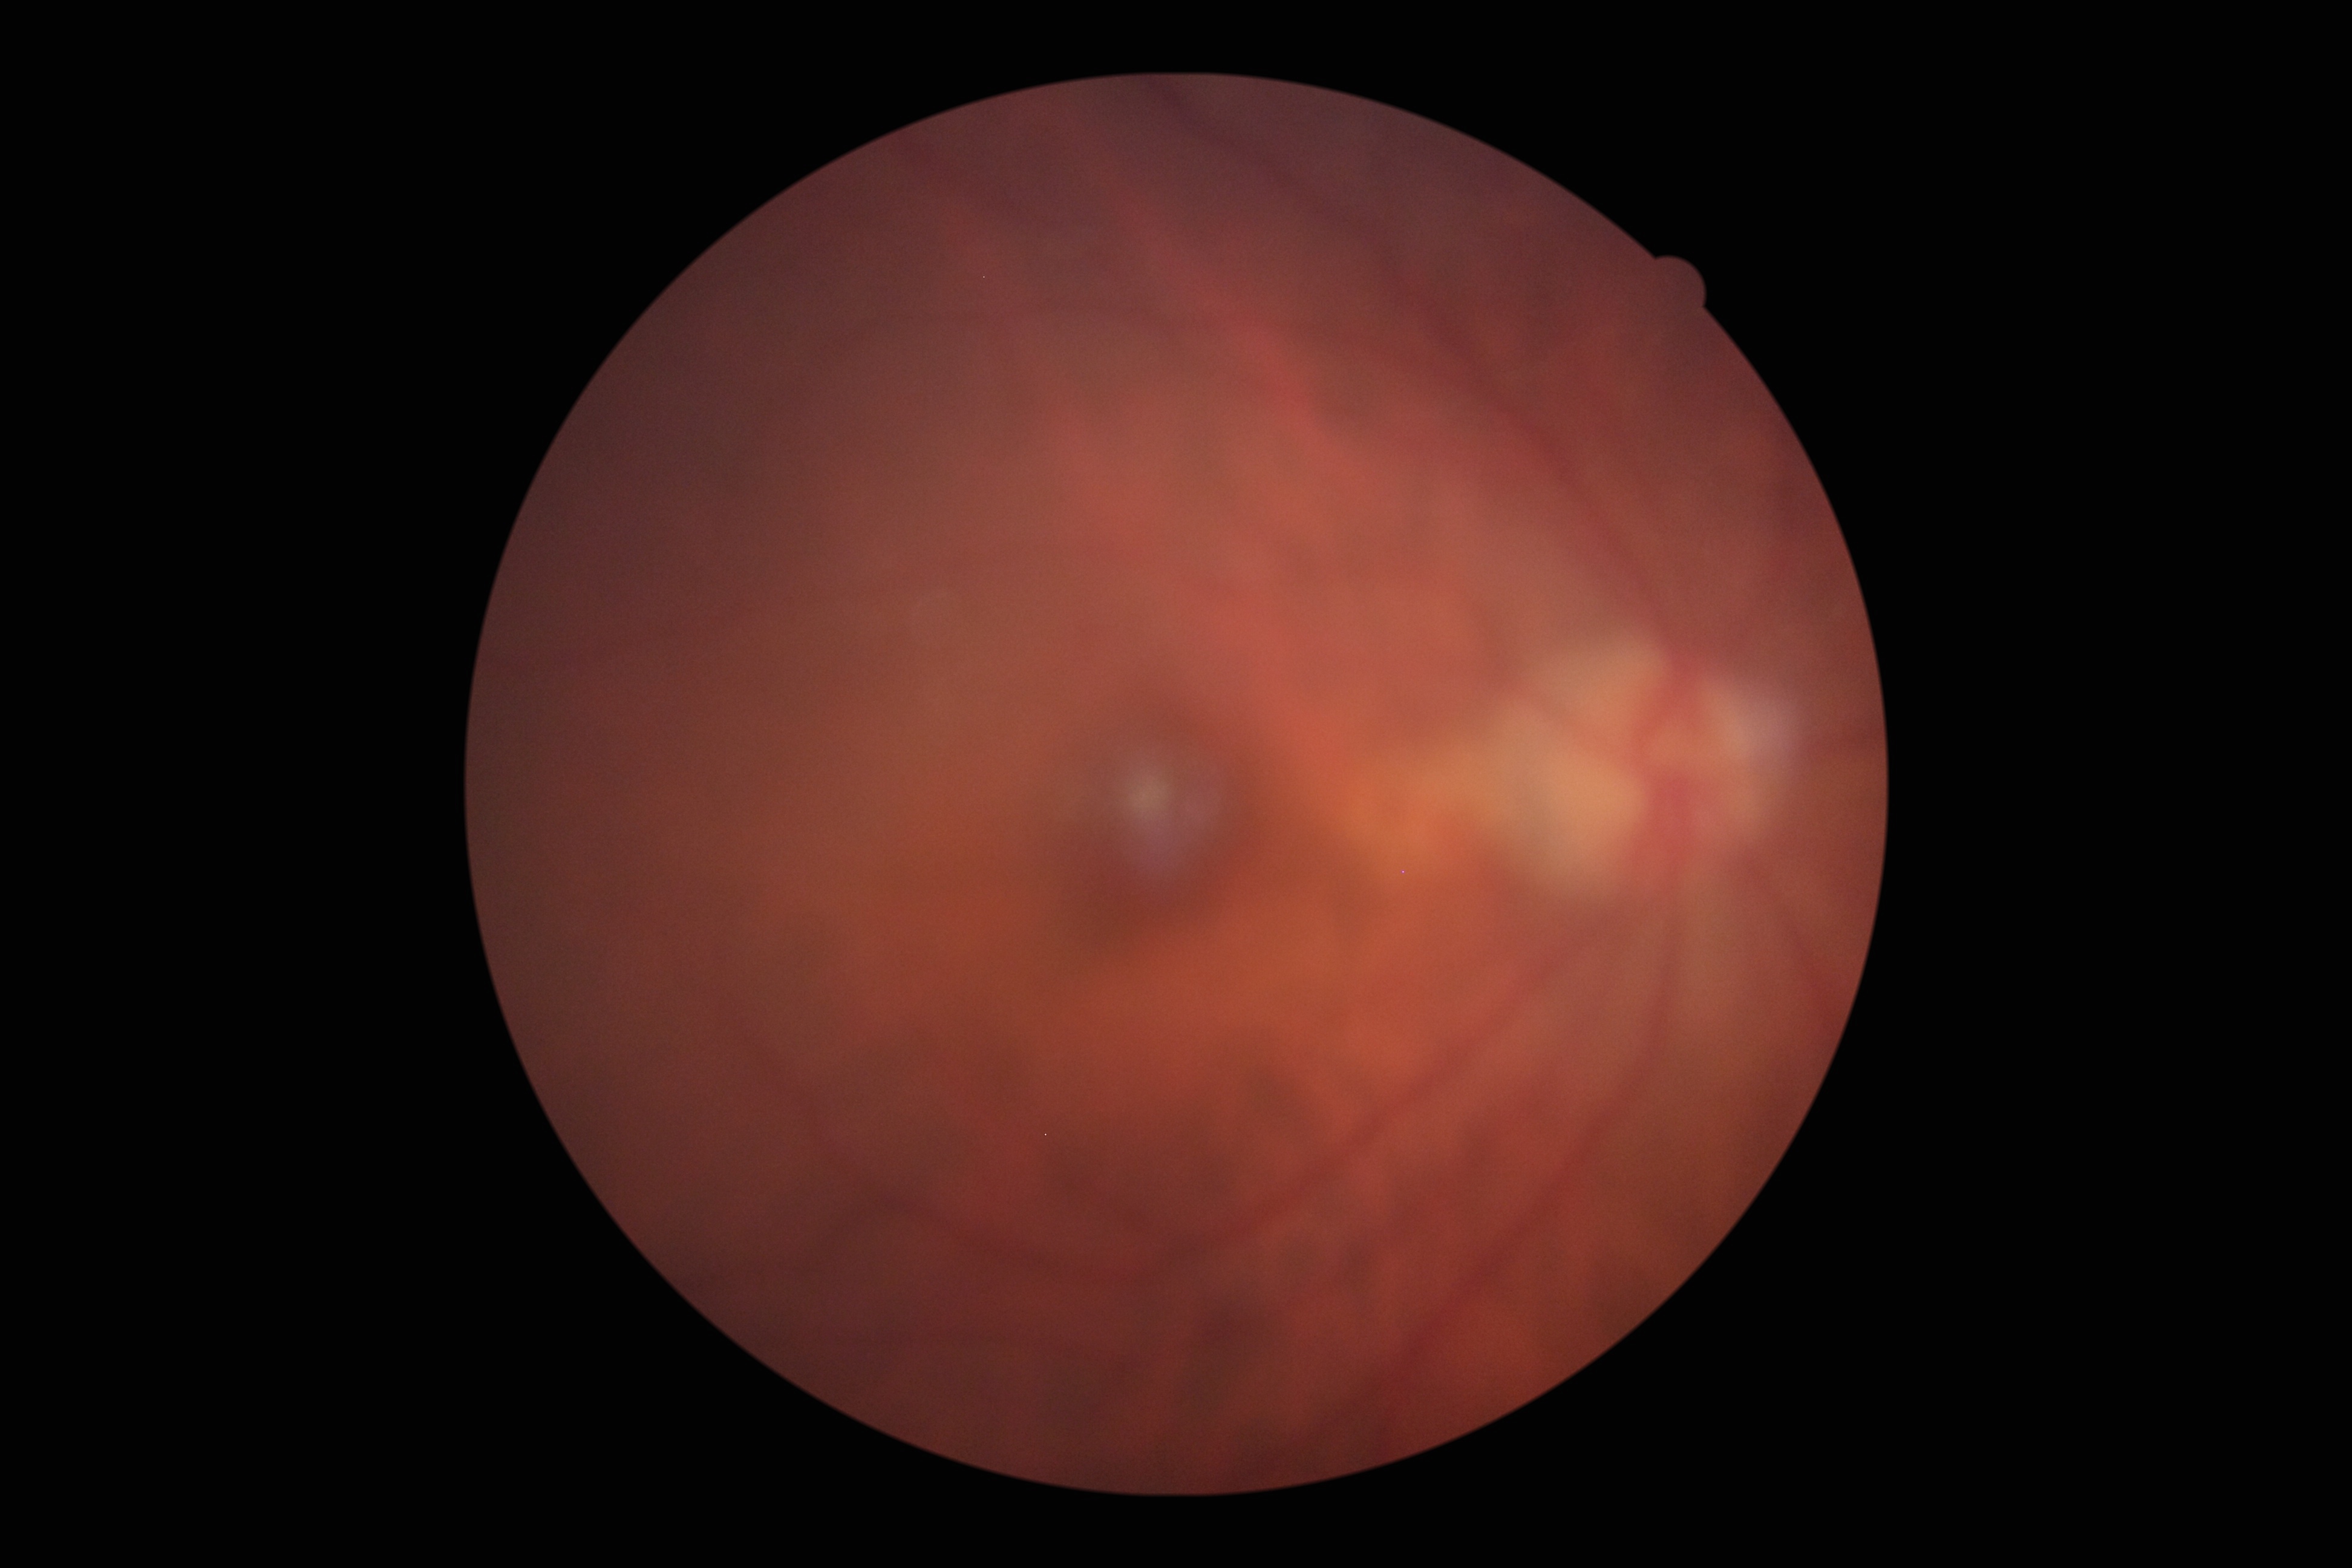 DR: no apparent diabetic retinopathy (grade 0).